45° field of view — 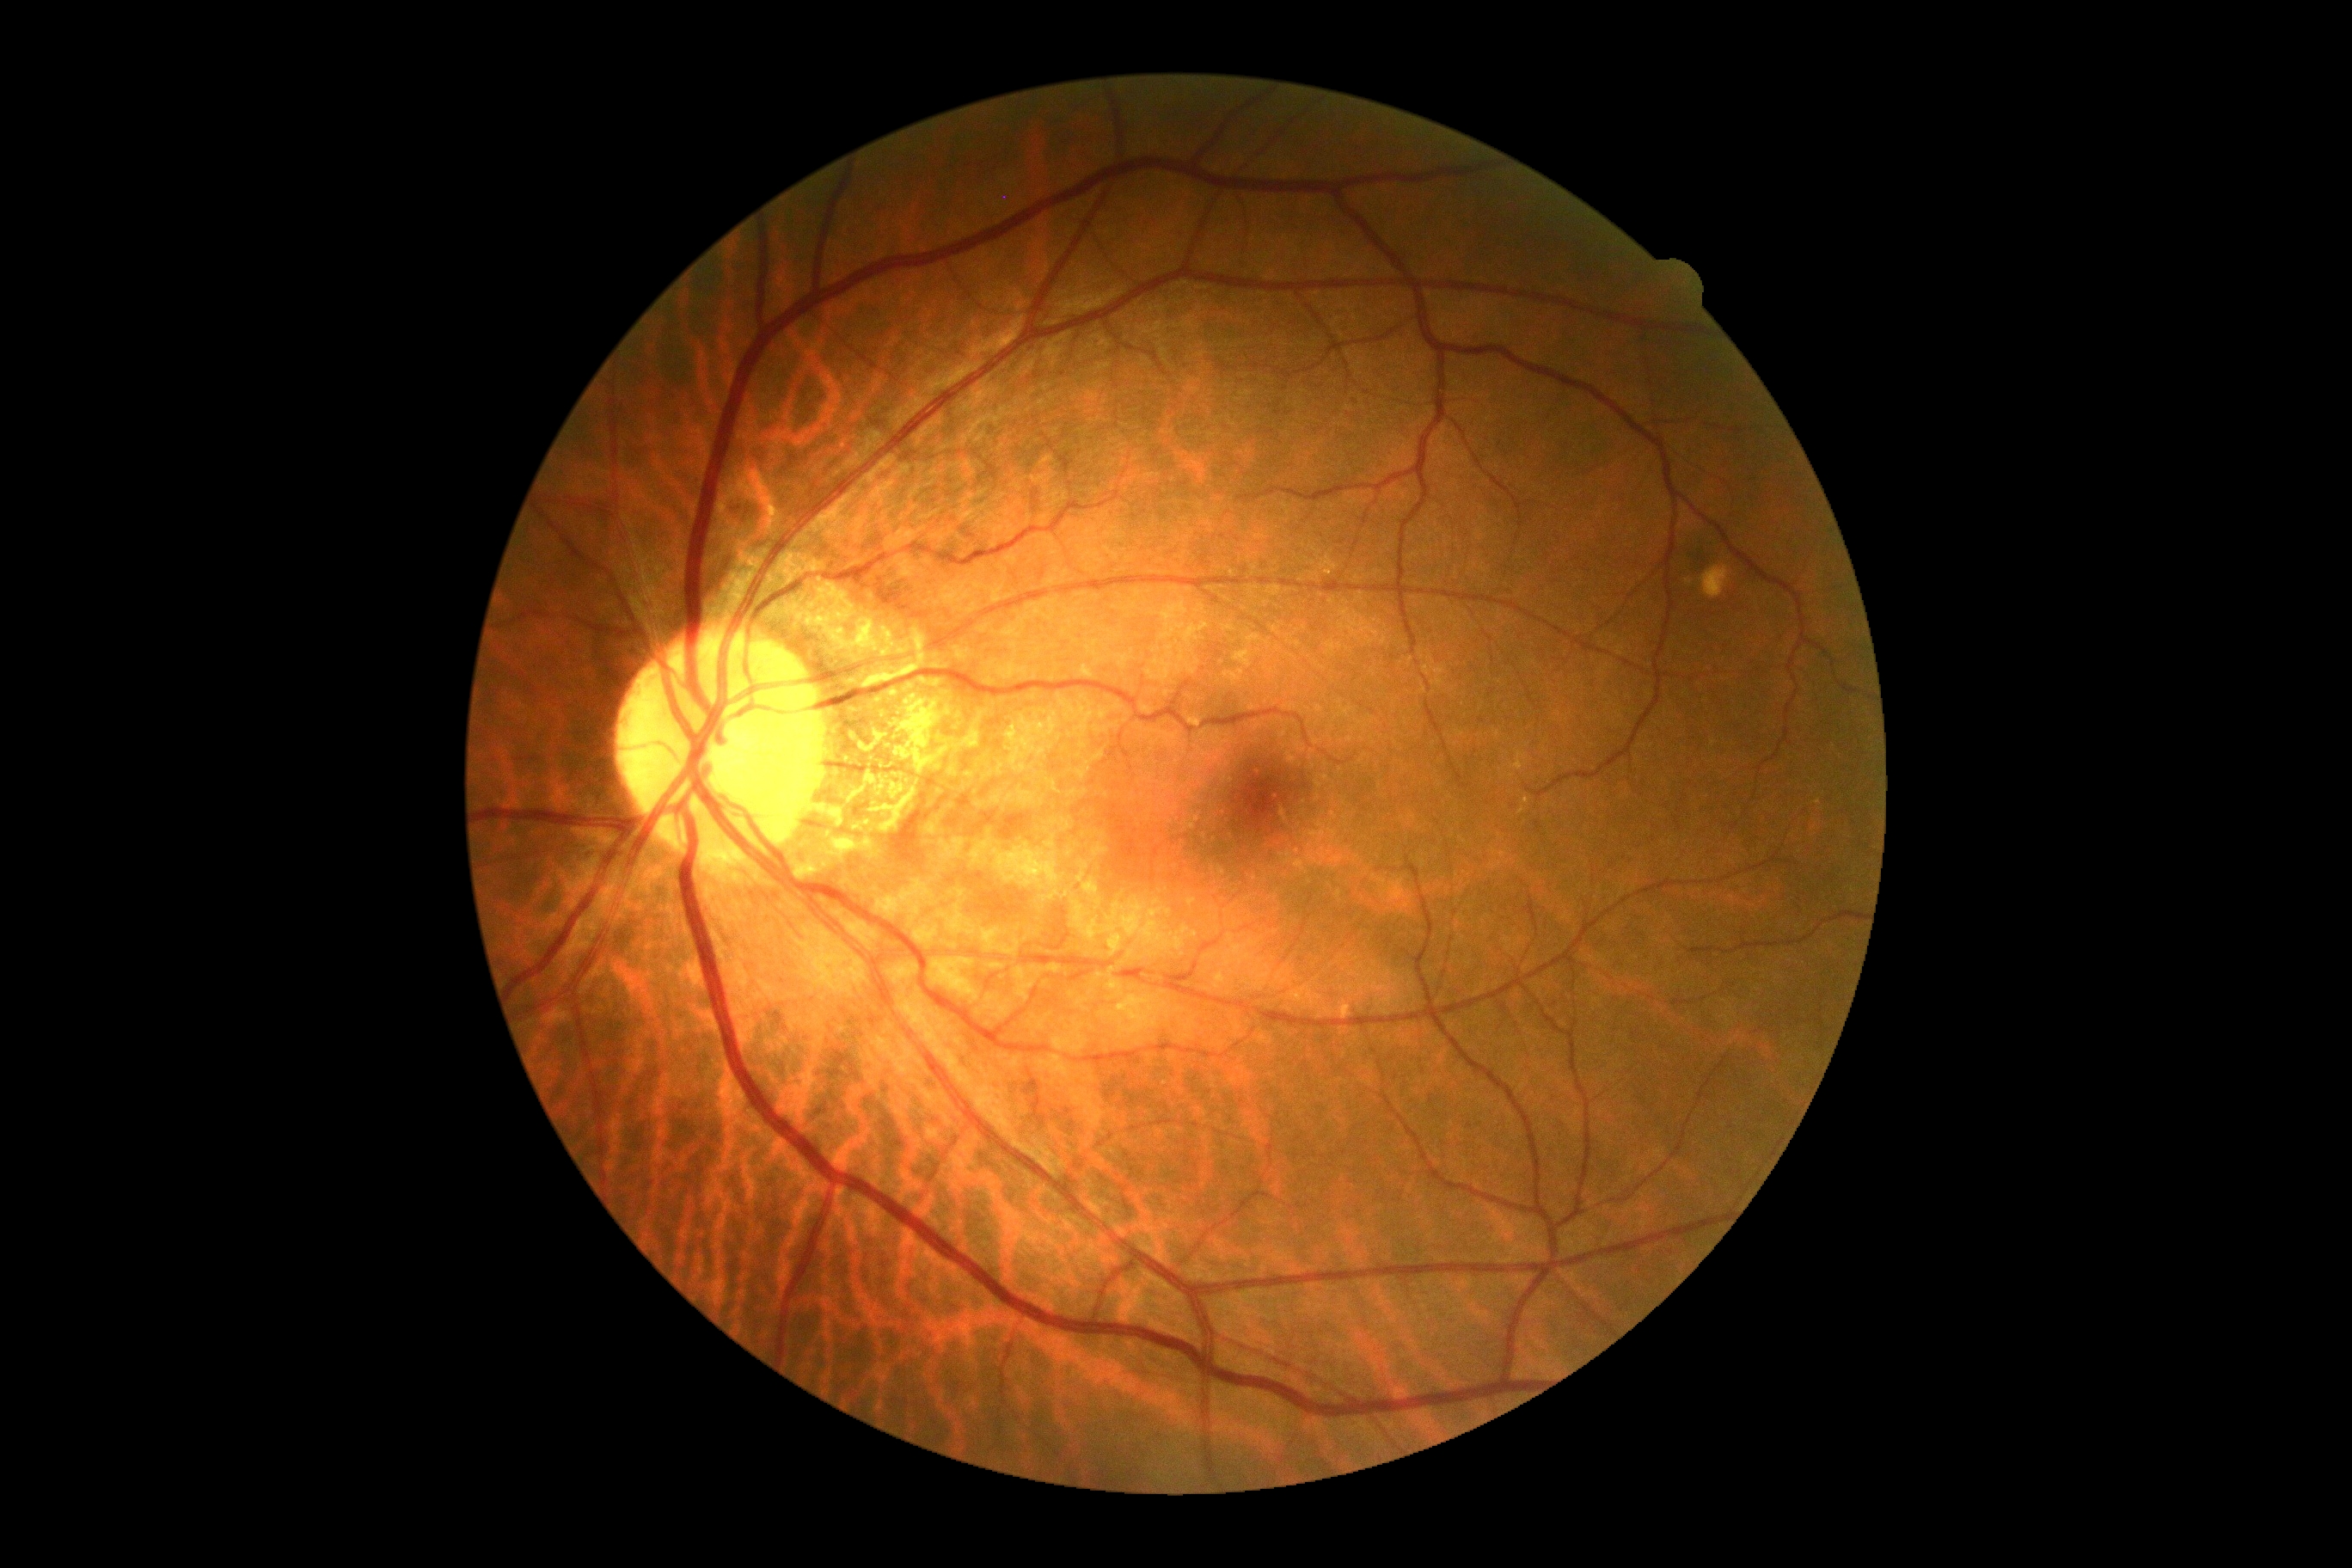
– diabetic retinopathy severity — 0/4